Davis DR grading · 45° FOV: 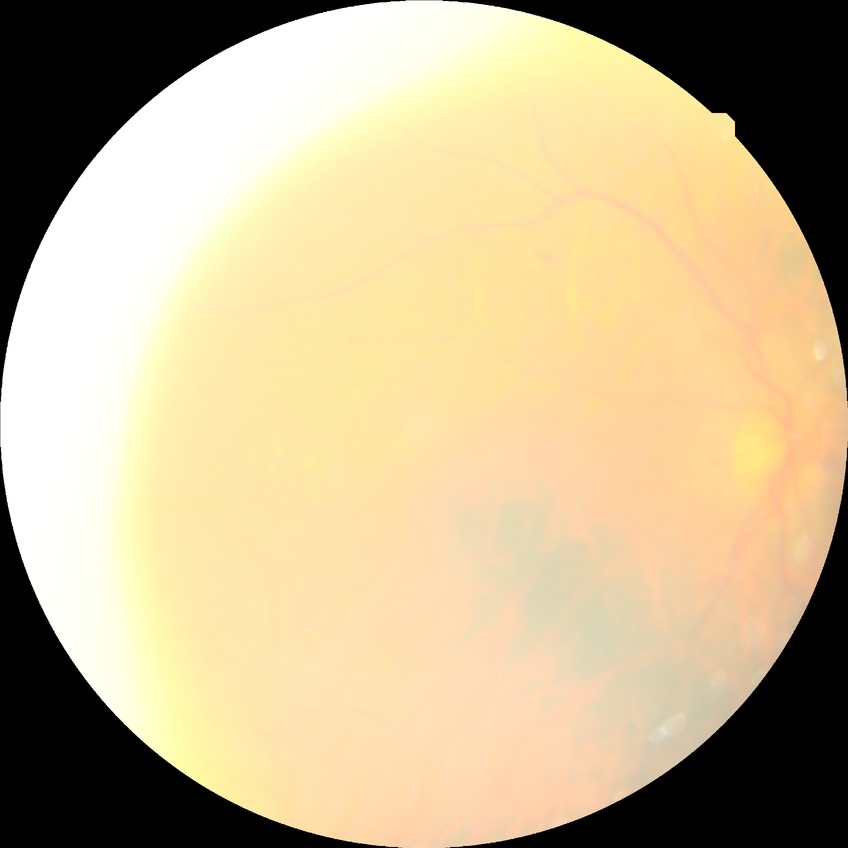
Diabetic retinopathy (DR) is SDR (simple diabetic retinopathy).